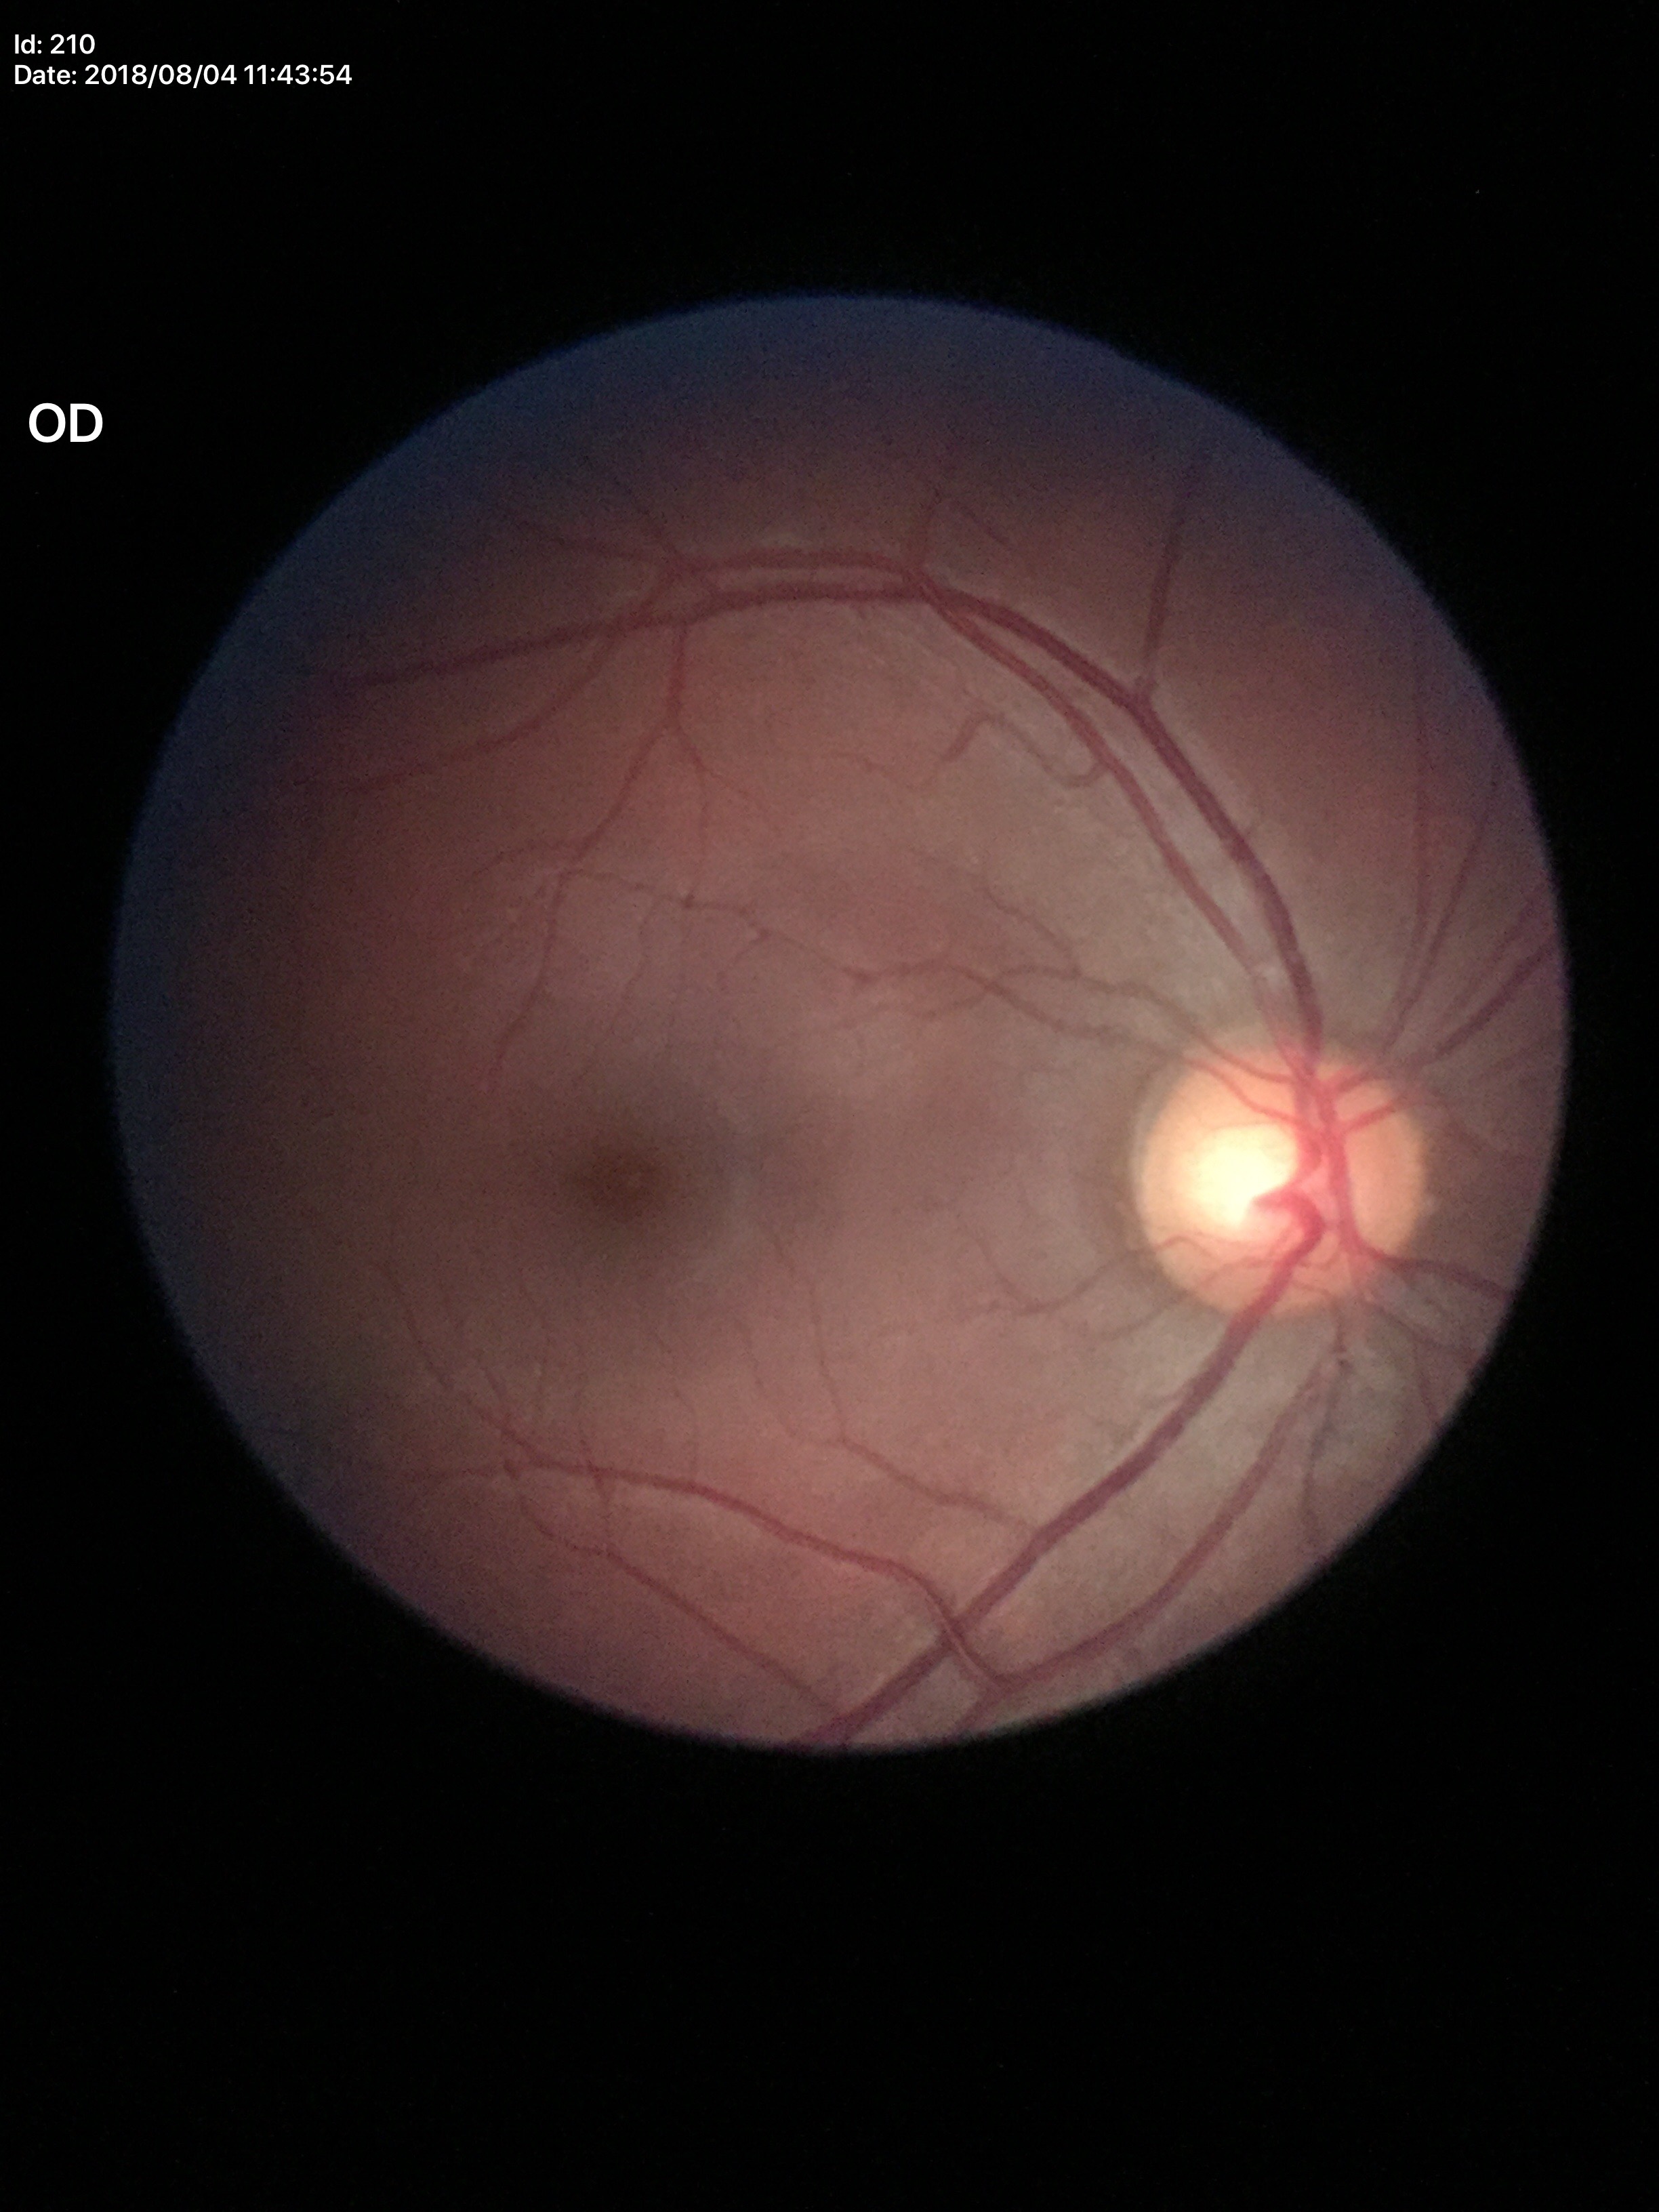

Vertical CDR (VCDR) of 0.58. No glaucomatous findings.